Color fundus photograph, FOV: 45 degrees, 2212x1659 — 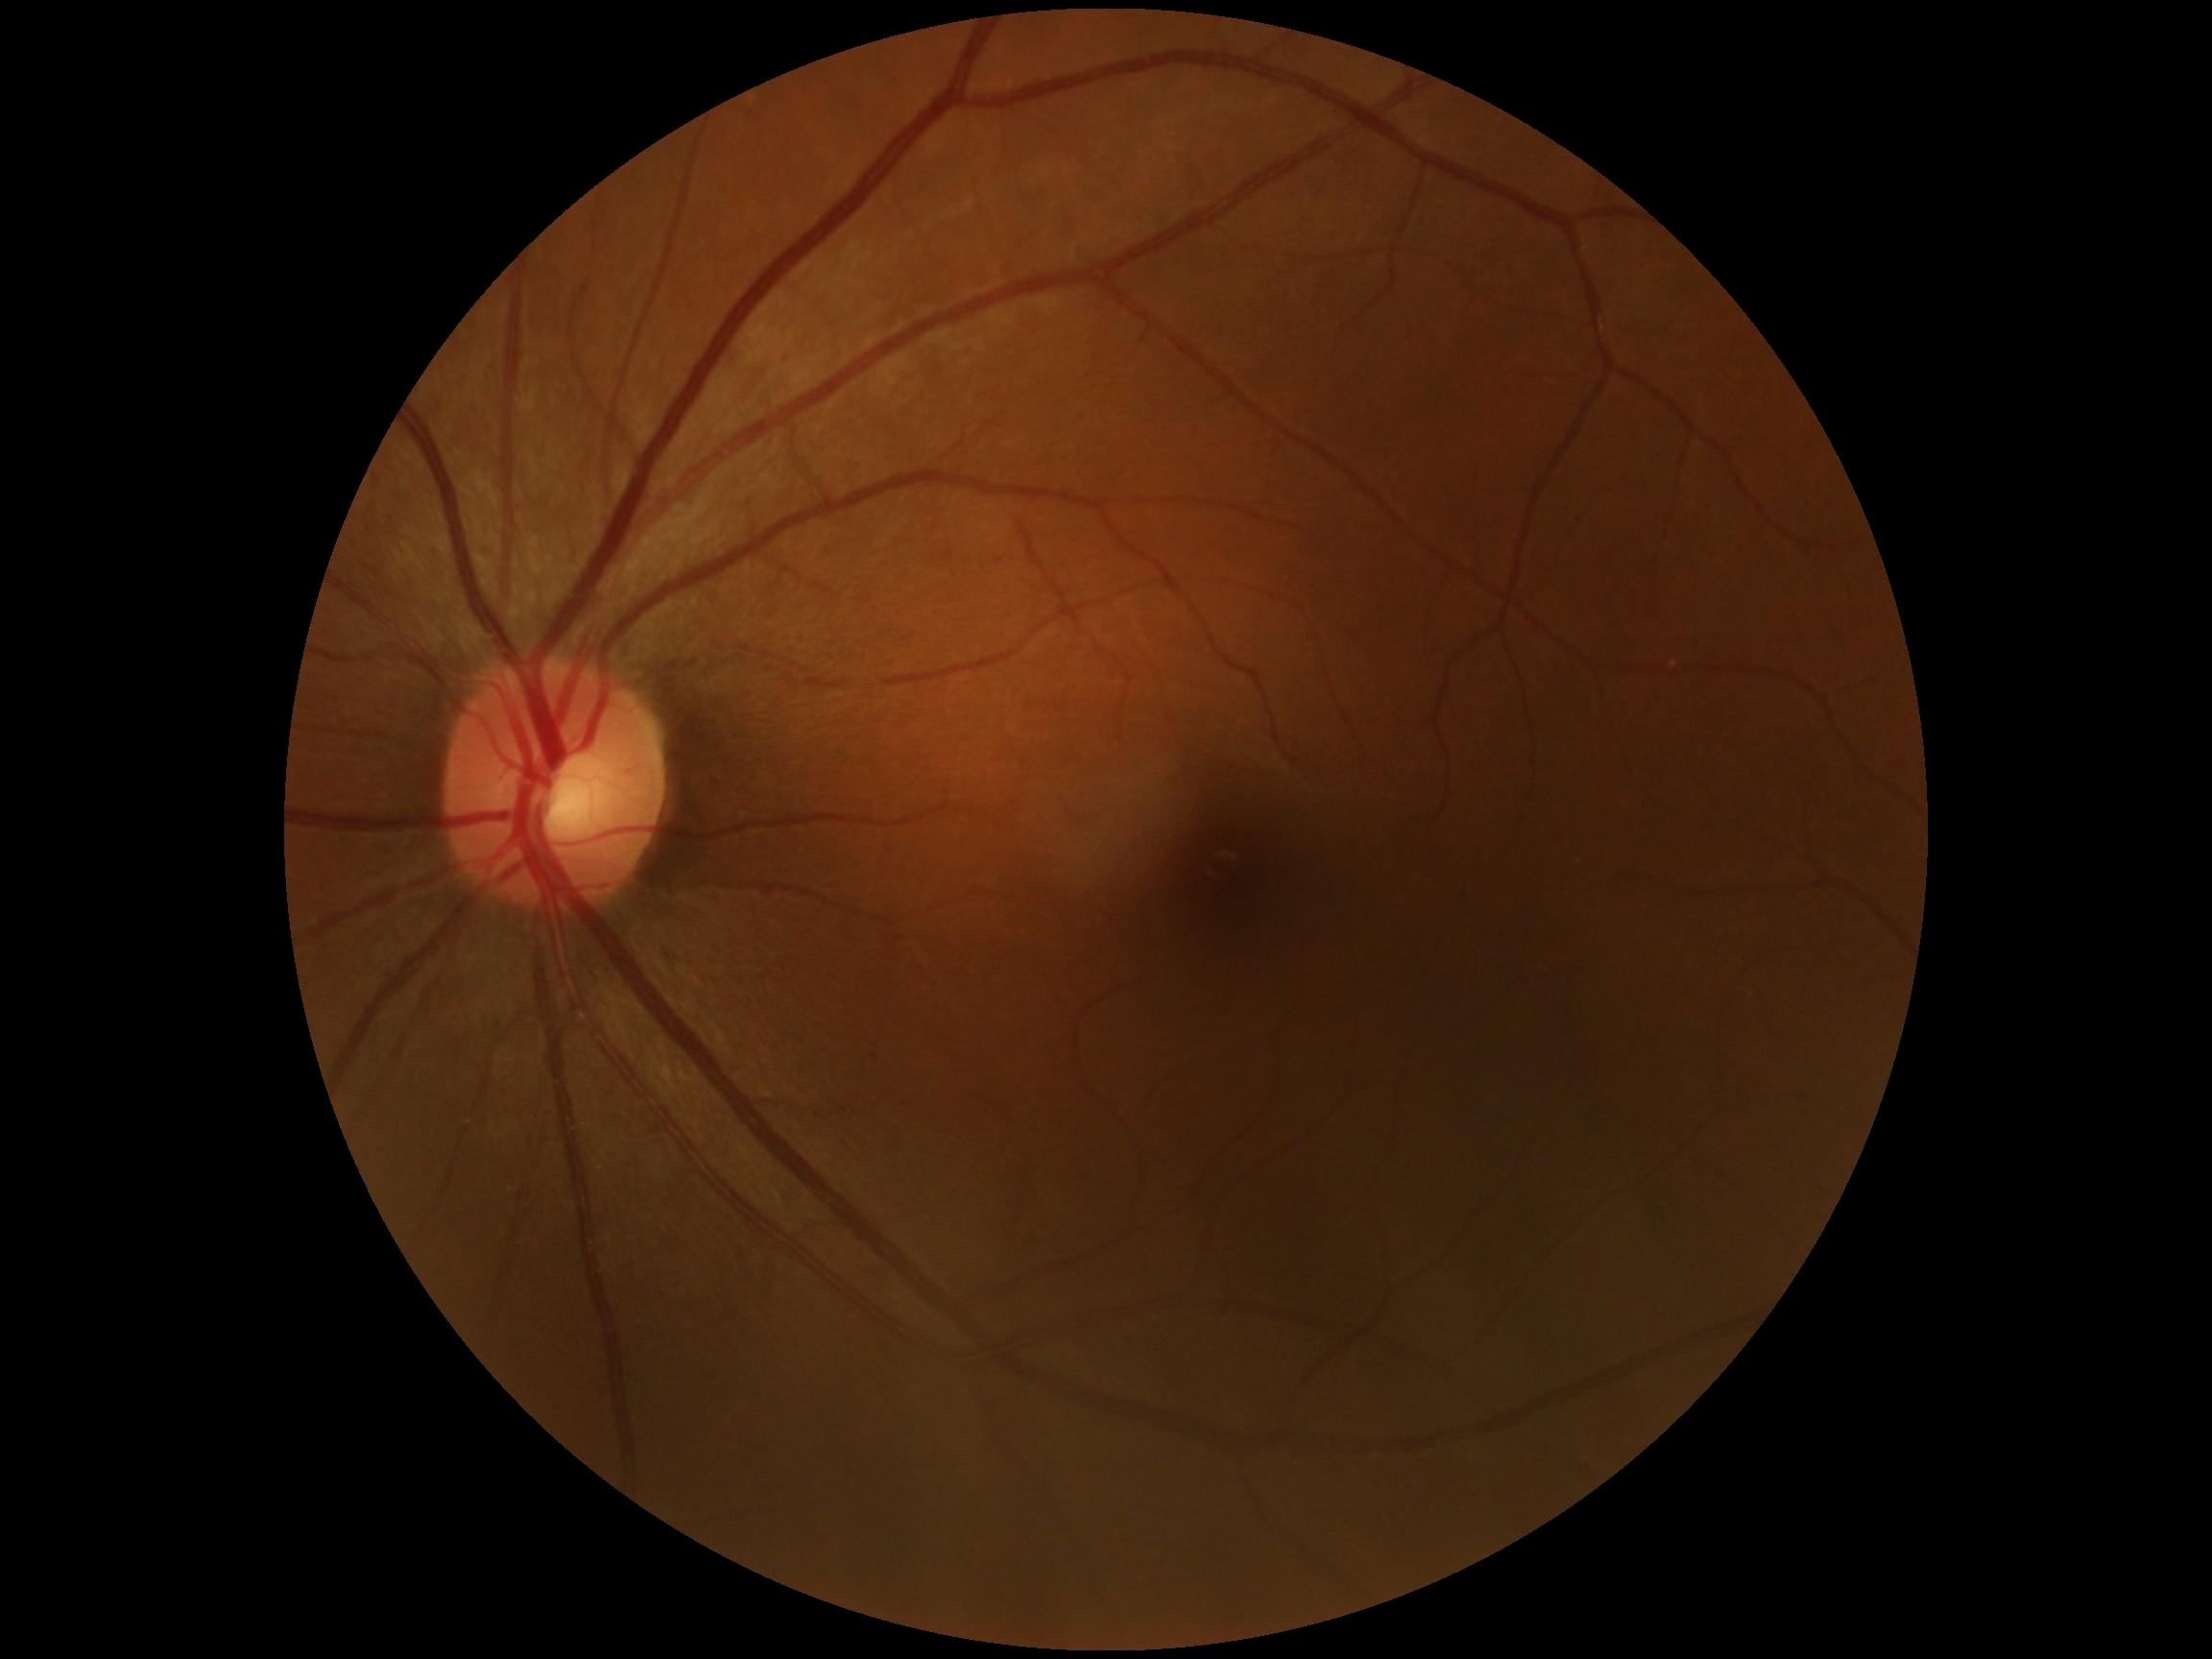
DR stage: grade 0
DR impression: no signs of DR